848 x 848 pixels.
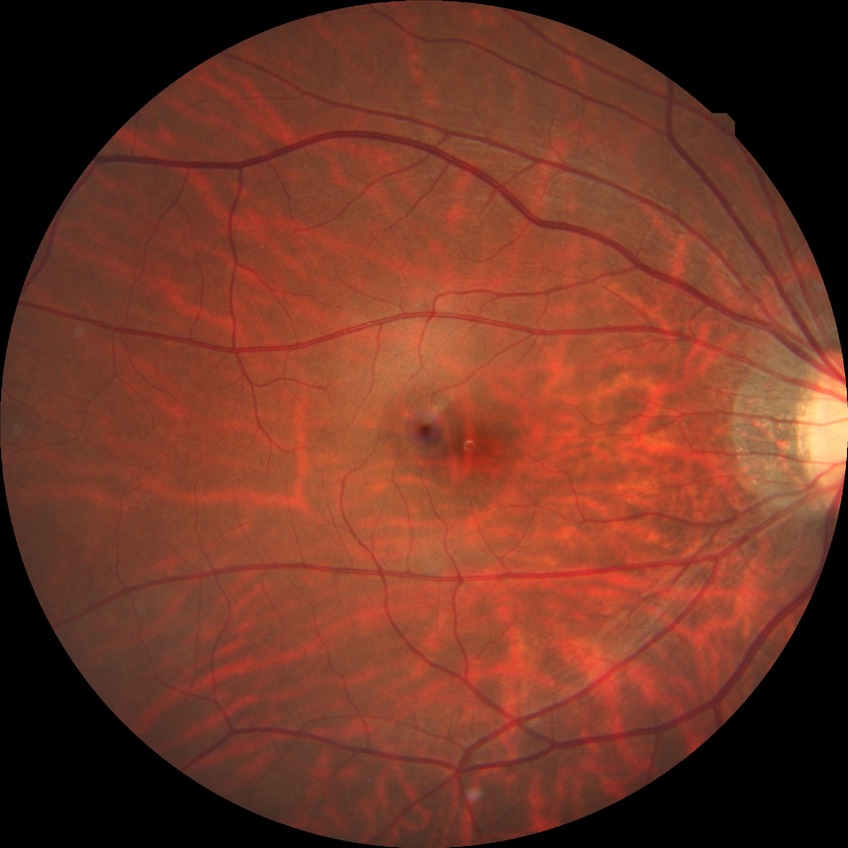
Diabetic retinopathy stage is no diabetic retinopathy.